Image size 640x480 · camera: Clarity RetCam 3 (130° FOV) · infant wide-field fundus photograph
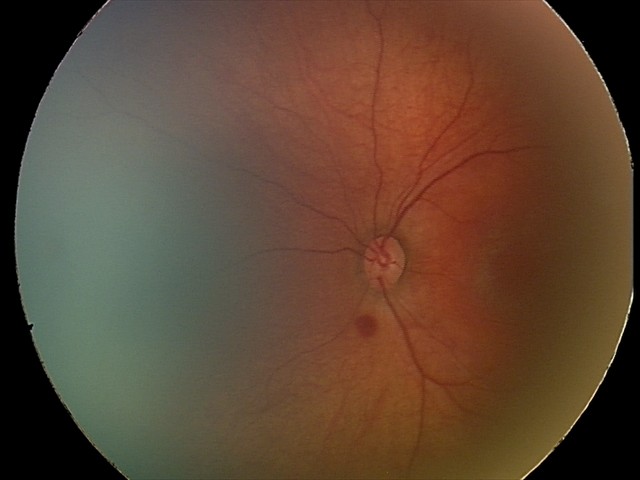 Series diagnosed as retinal hemorrhages.